Wide-field fundus photograph of an infant; 640x480px: 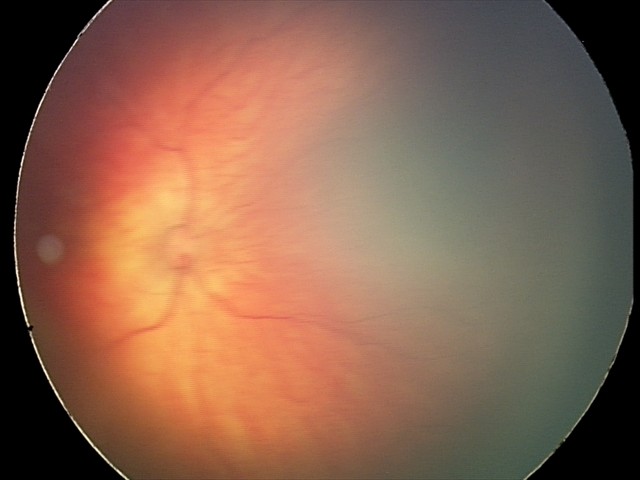

From an examination with diagnosis of retinal hemorrhages.